NIDEK AFC-230 · nonmydriatic fundus photograph — 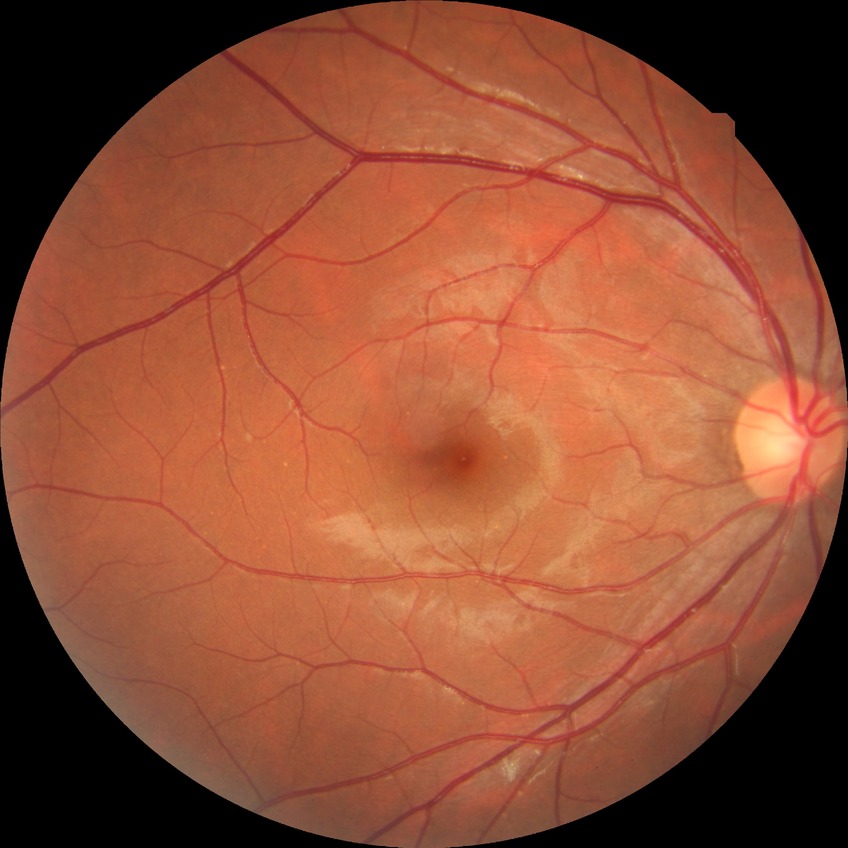

Diabetic retinopathy (DR) is NDR (no diabetic retinopathy).